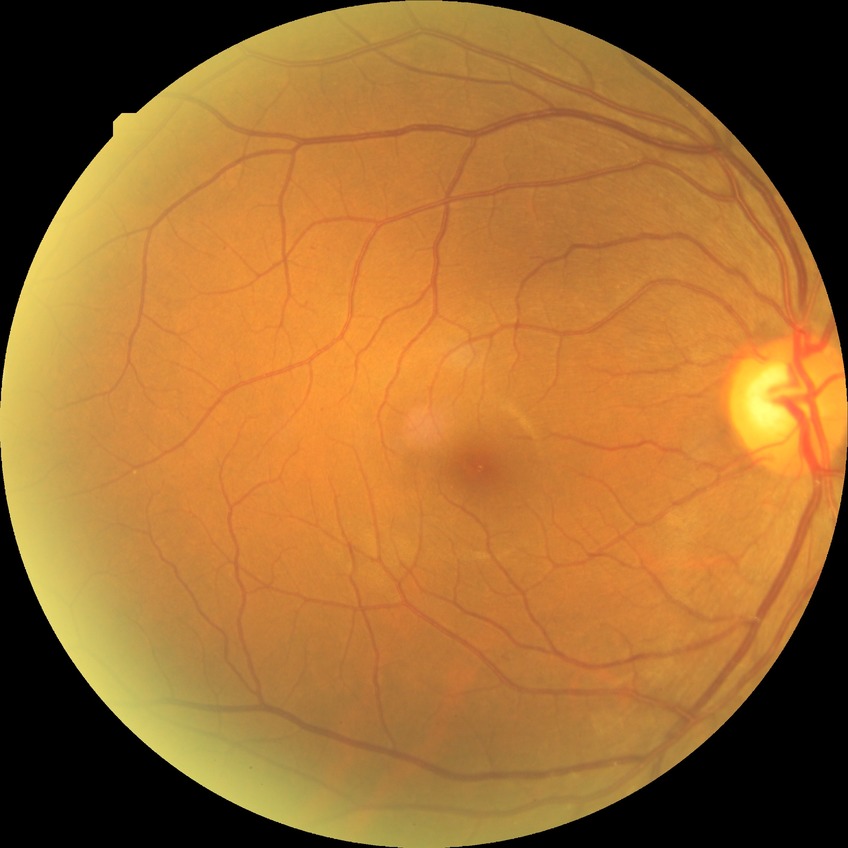
Diabetic retinopathy severity: simple diabetic retinopathy.